Retinal fundus photograph, nonmydriatic fundus photograph, 45° FOV: 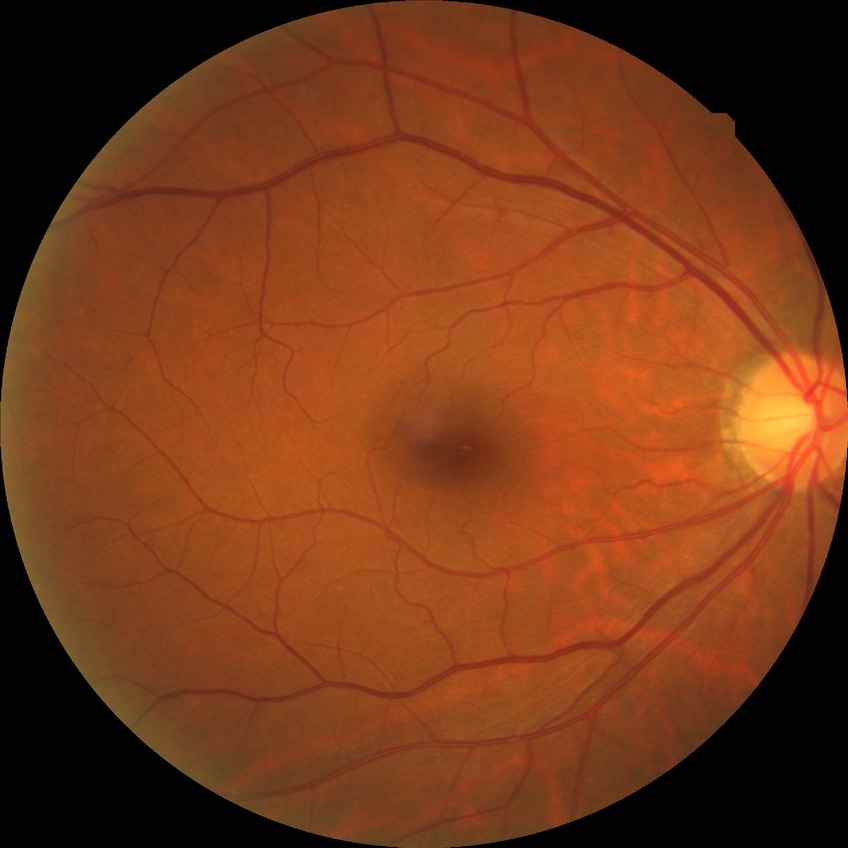 Diabetic retinopathy (DR): no diabetic retinopathy (NDR).